No pharmacologic dilation, image size 848x848, CFP, DR severity per modified Davis staging, 45° FOV — 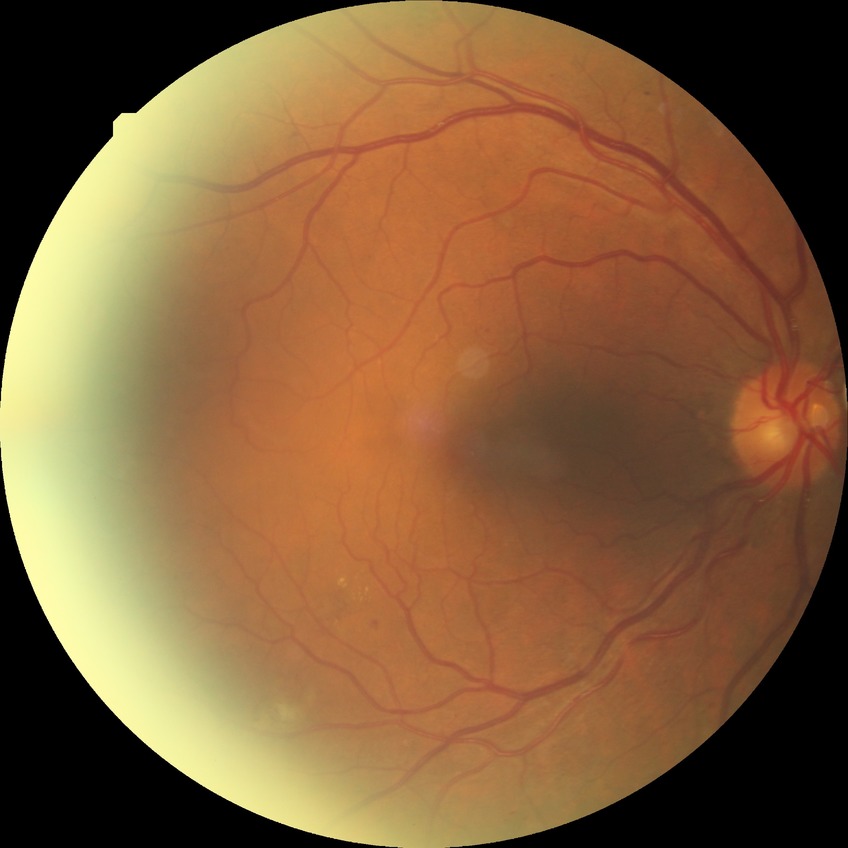

davis_grade: SDR (simple diabetic retinopathy)